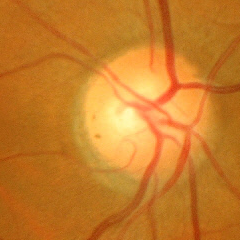
Fundus appearance consistent with no glaucoma.